1960 by 1897 pixels · FOV: 45 degrees.
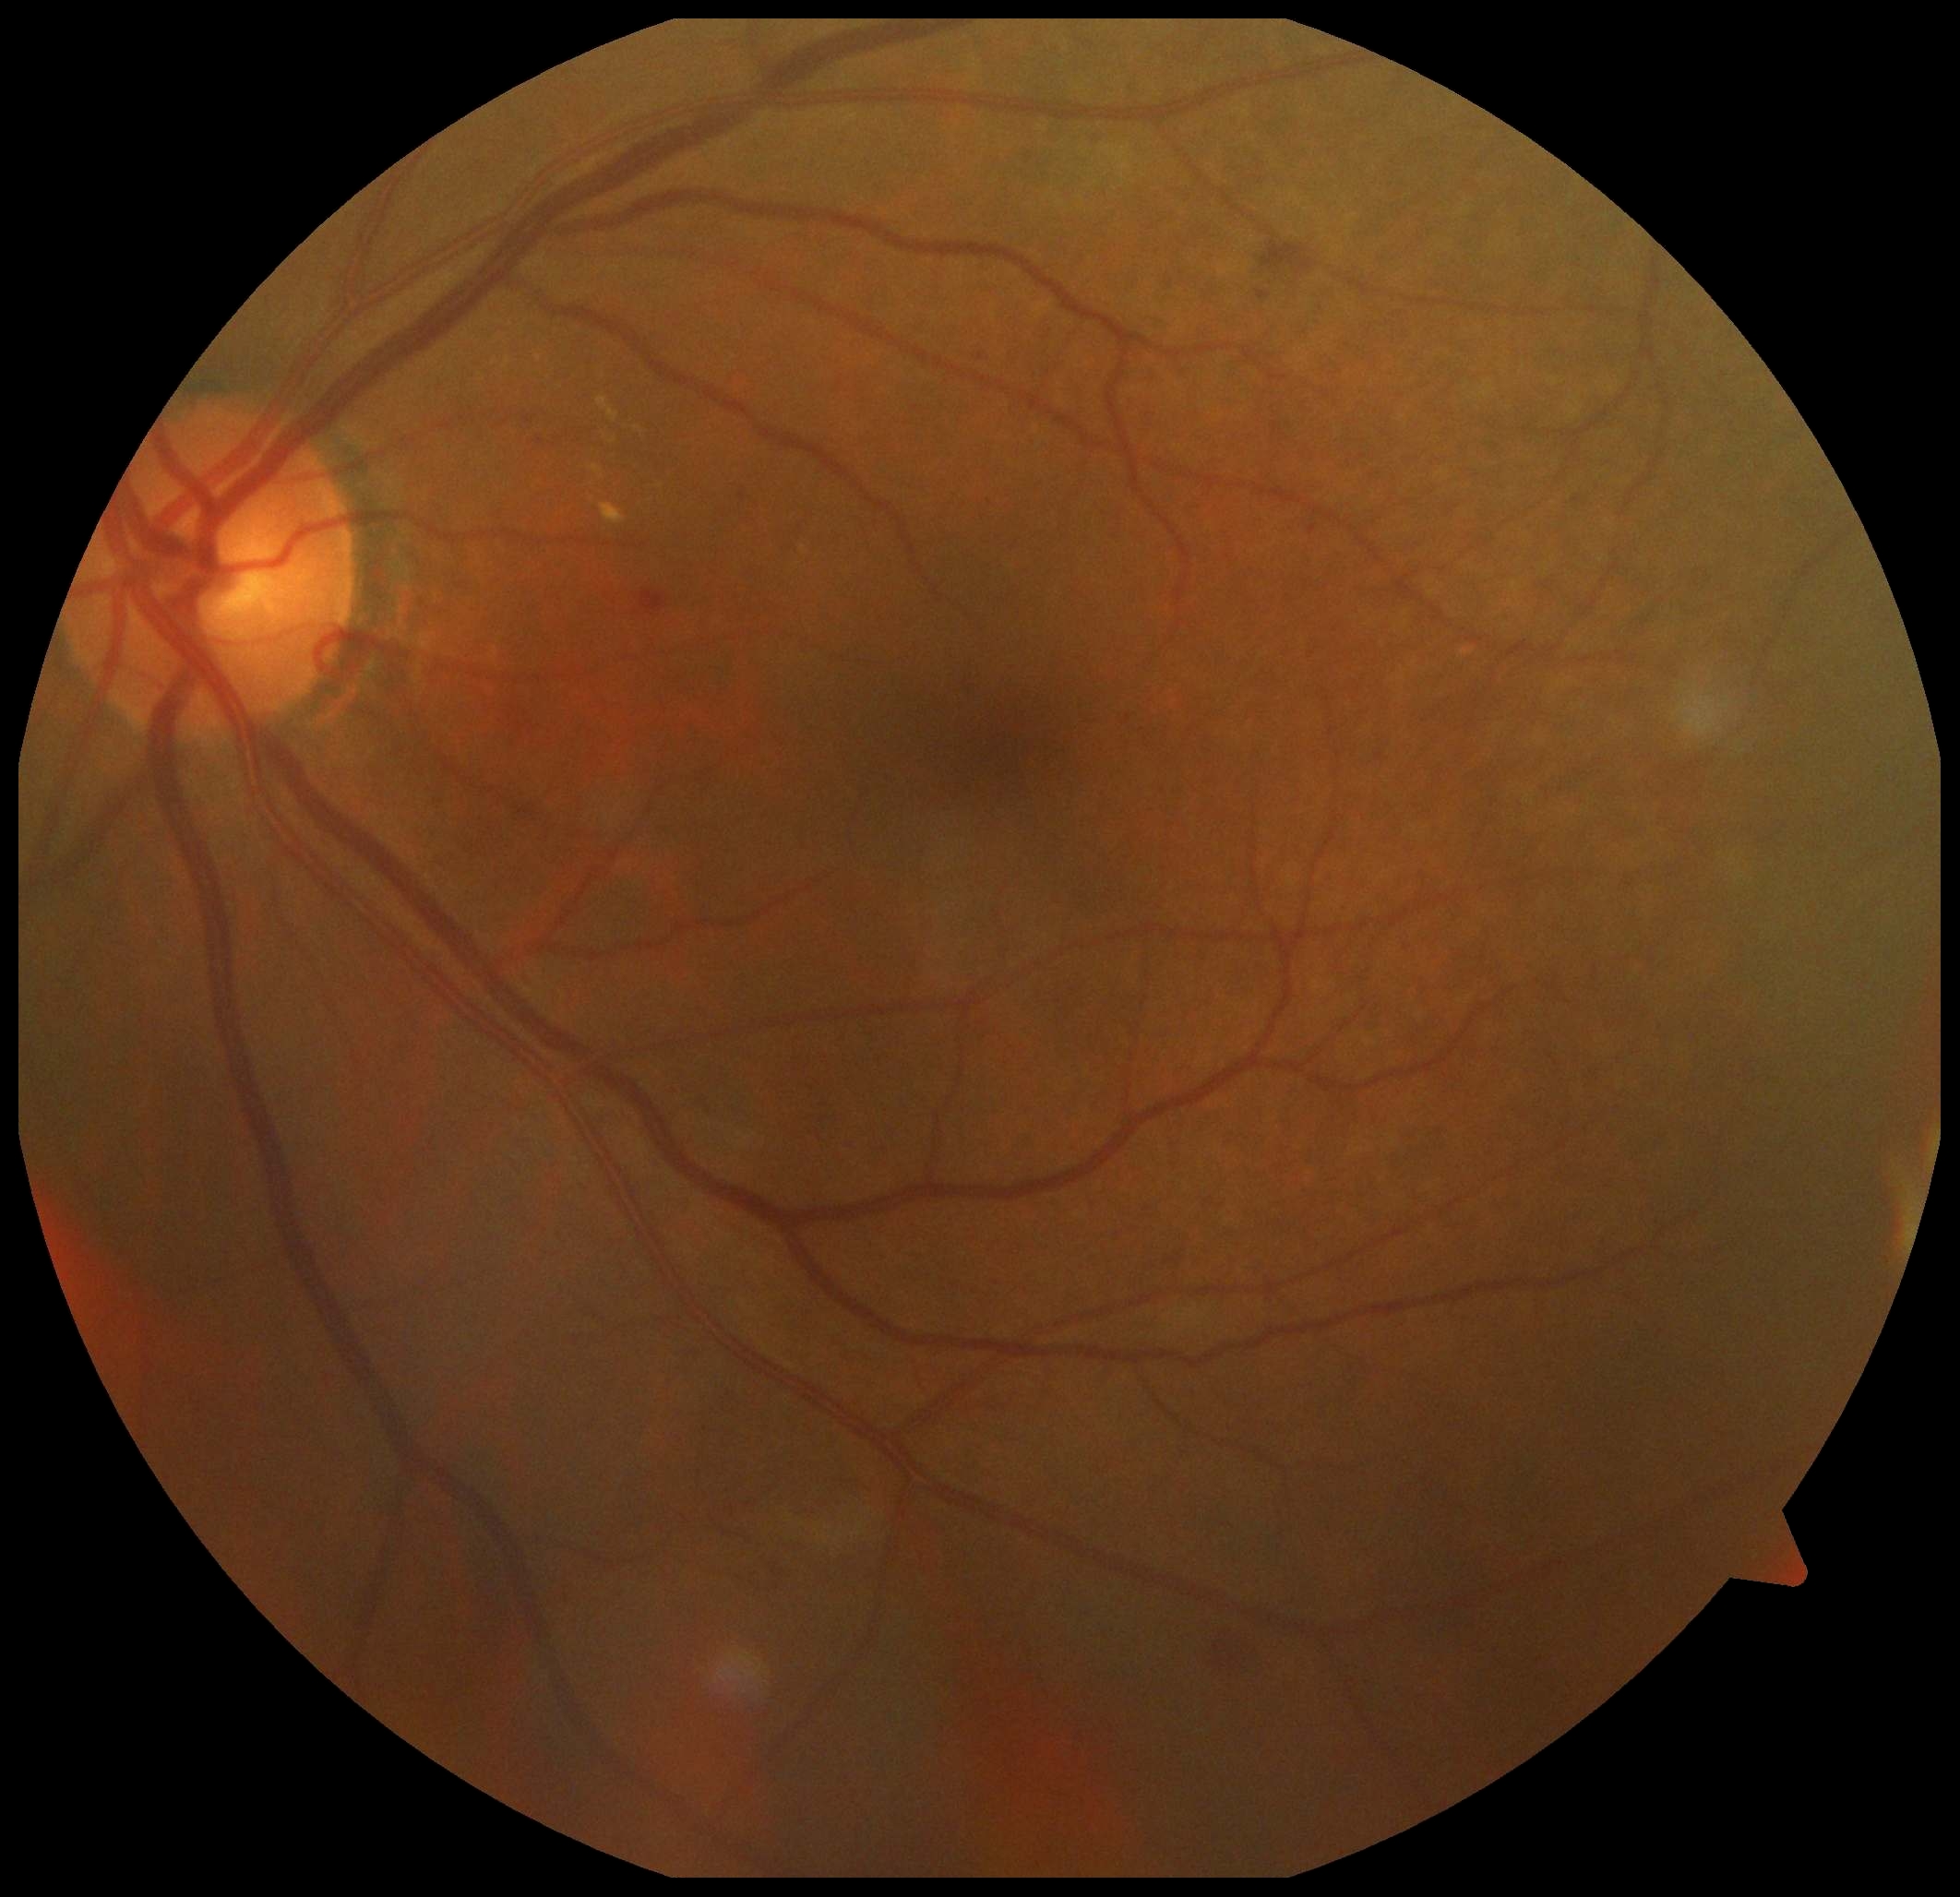

{
  "dr_grade": "2 — more than just microaneurysms but less than severe NPDR"
}